Retinal fundus photograph, 45-degree field of view.
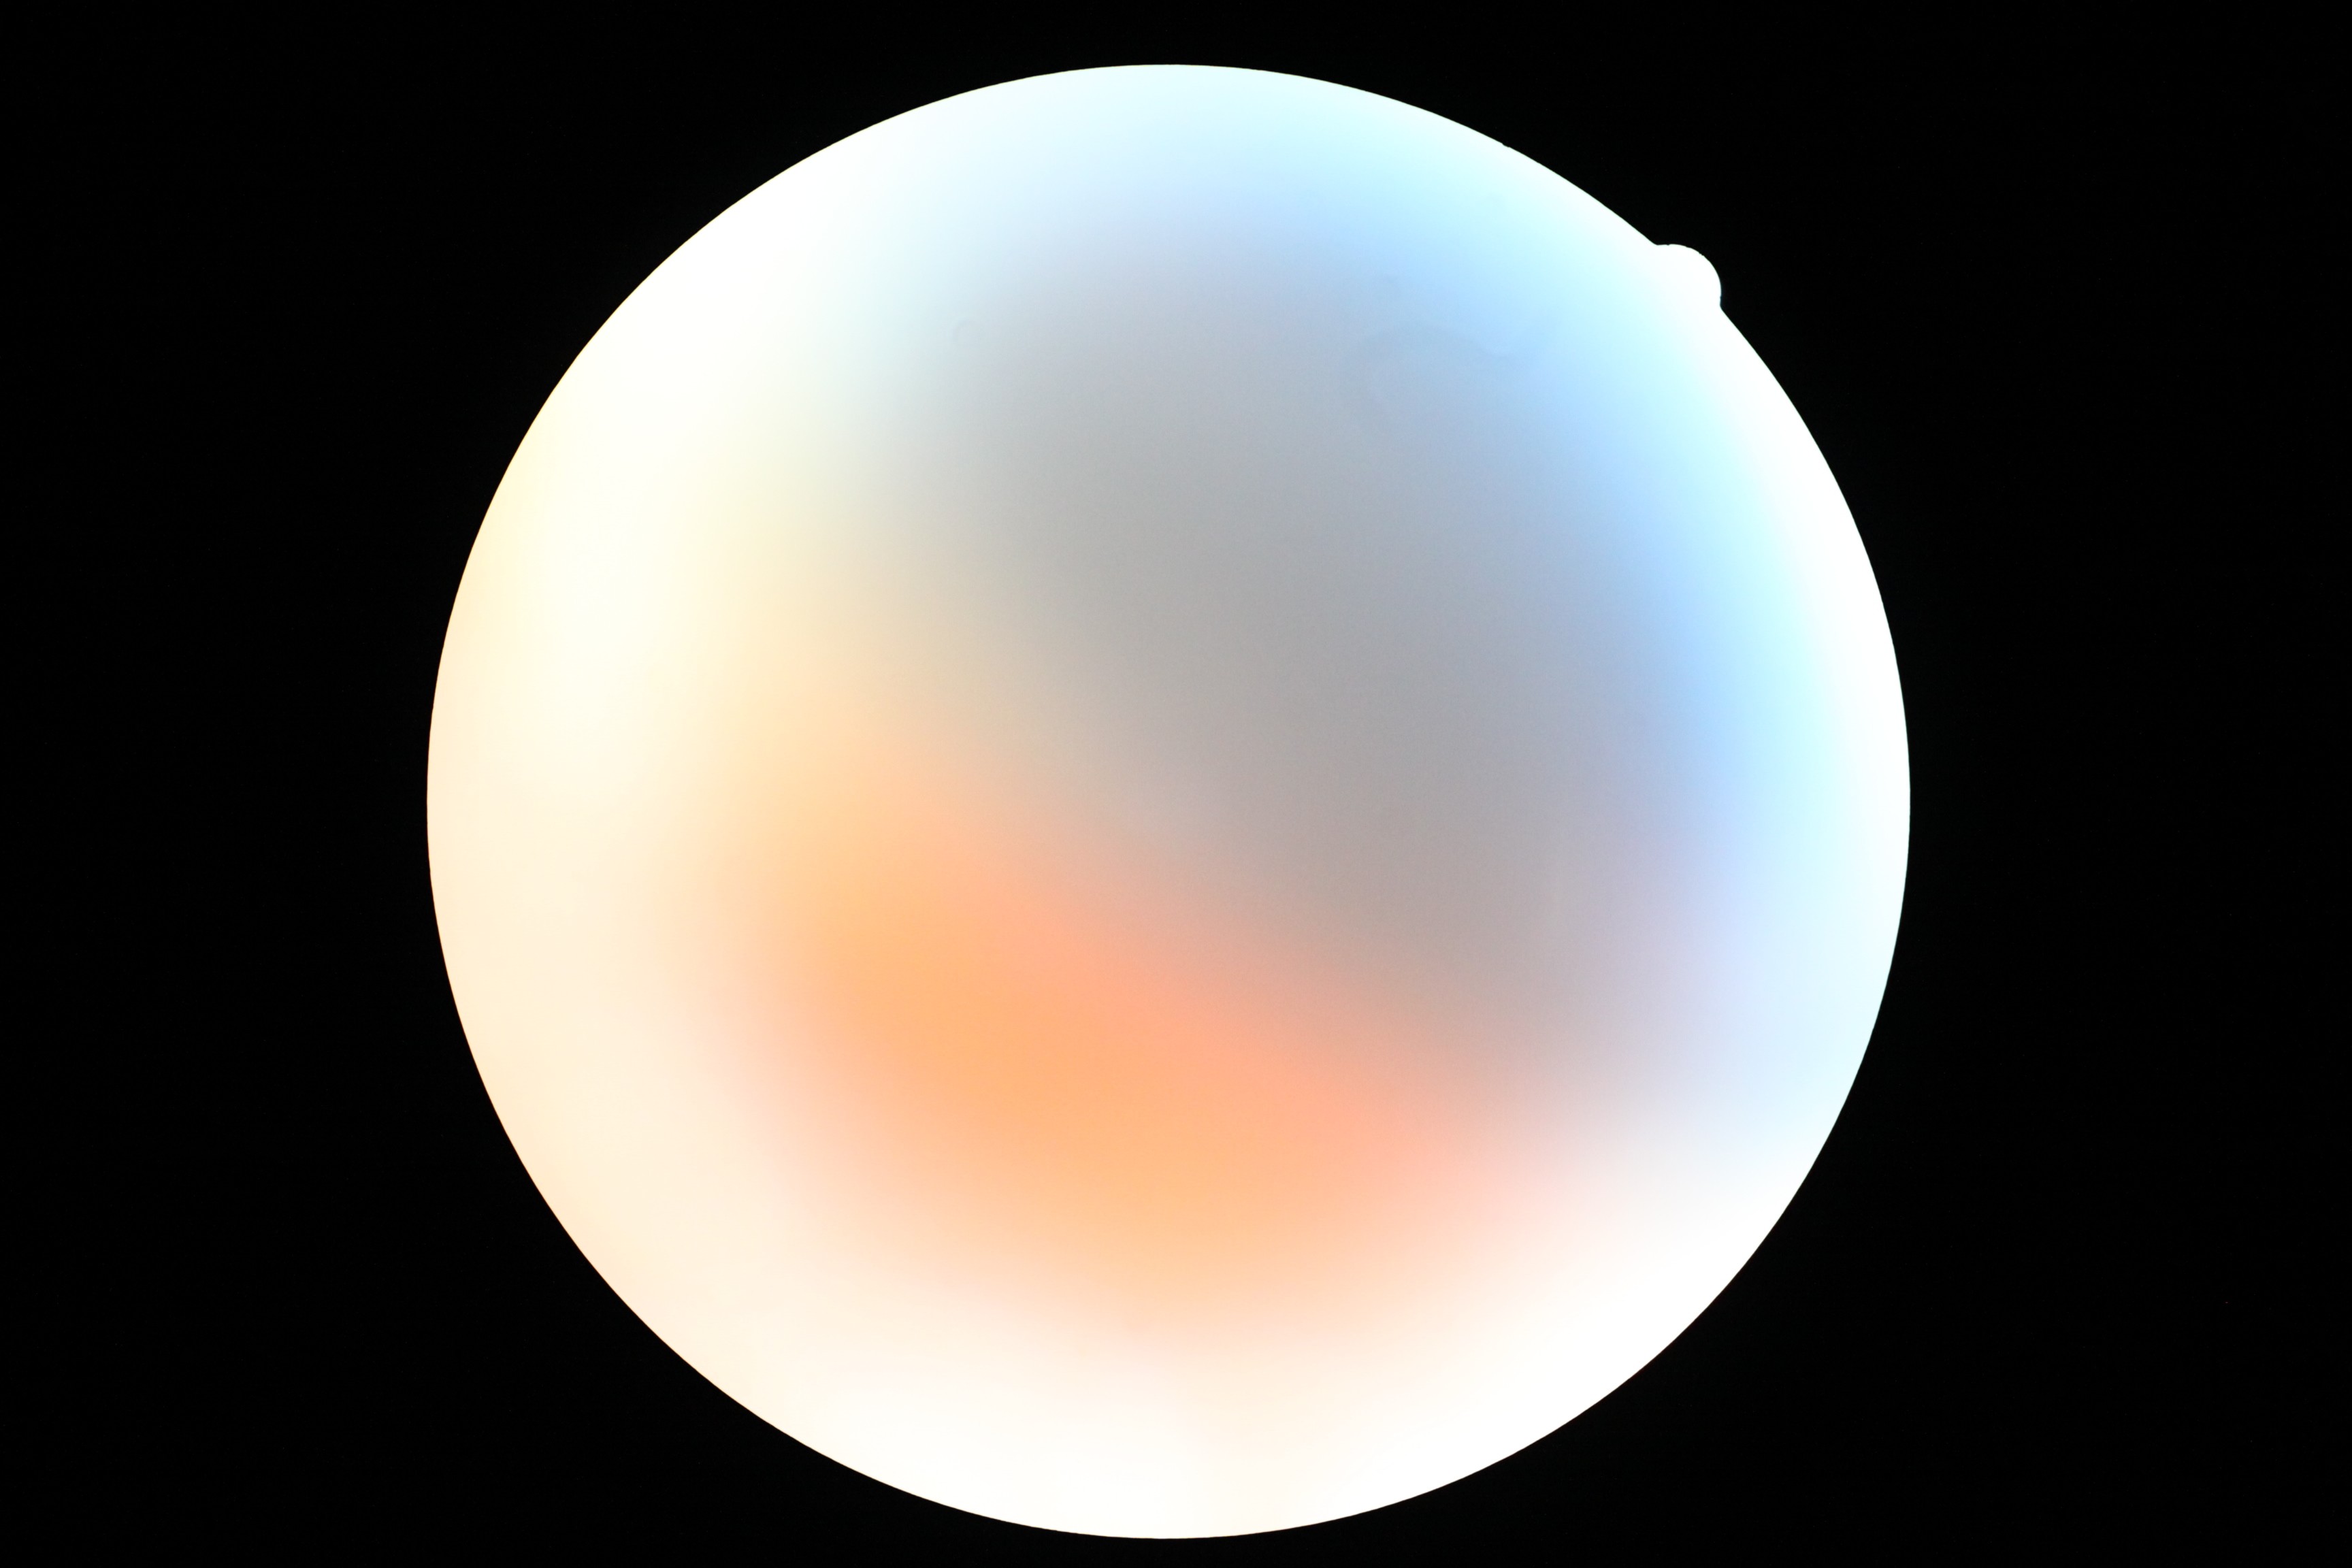

retinopathy@ungradable due to poor image quality.